Color fundus photograph: 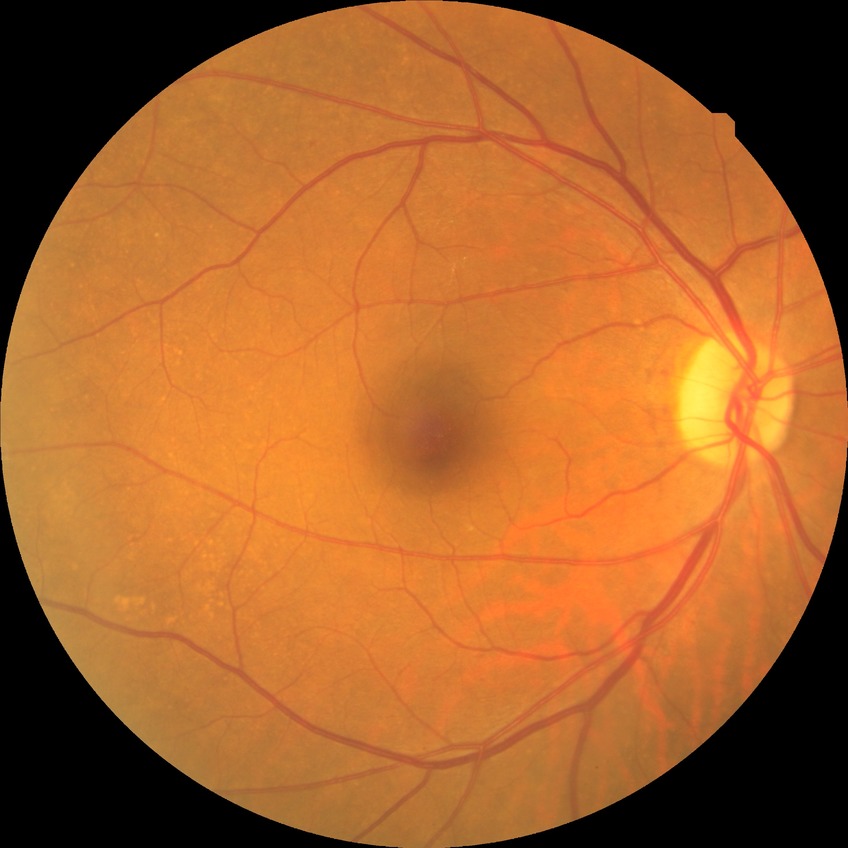

Diabetic retinopathy (DR) is NDR (no diabetic retinopathy).